2048x1536px
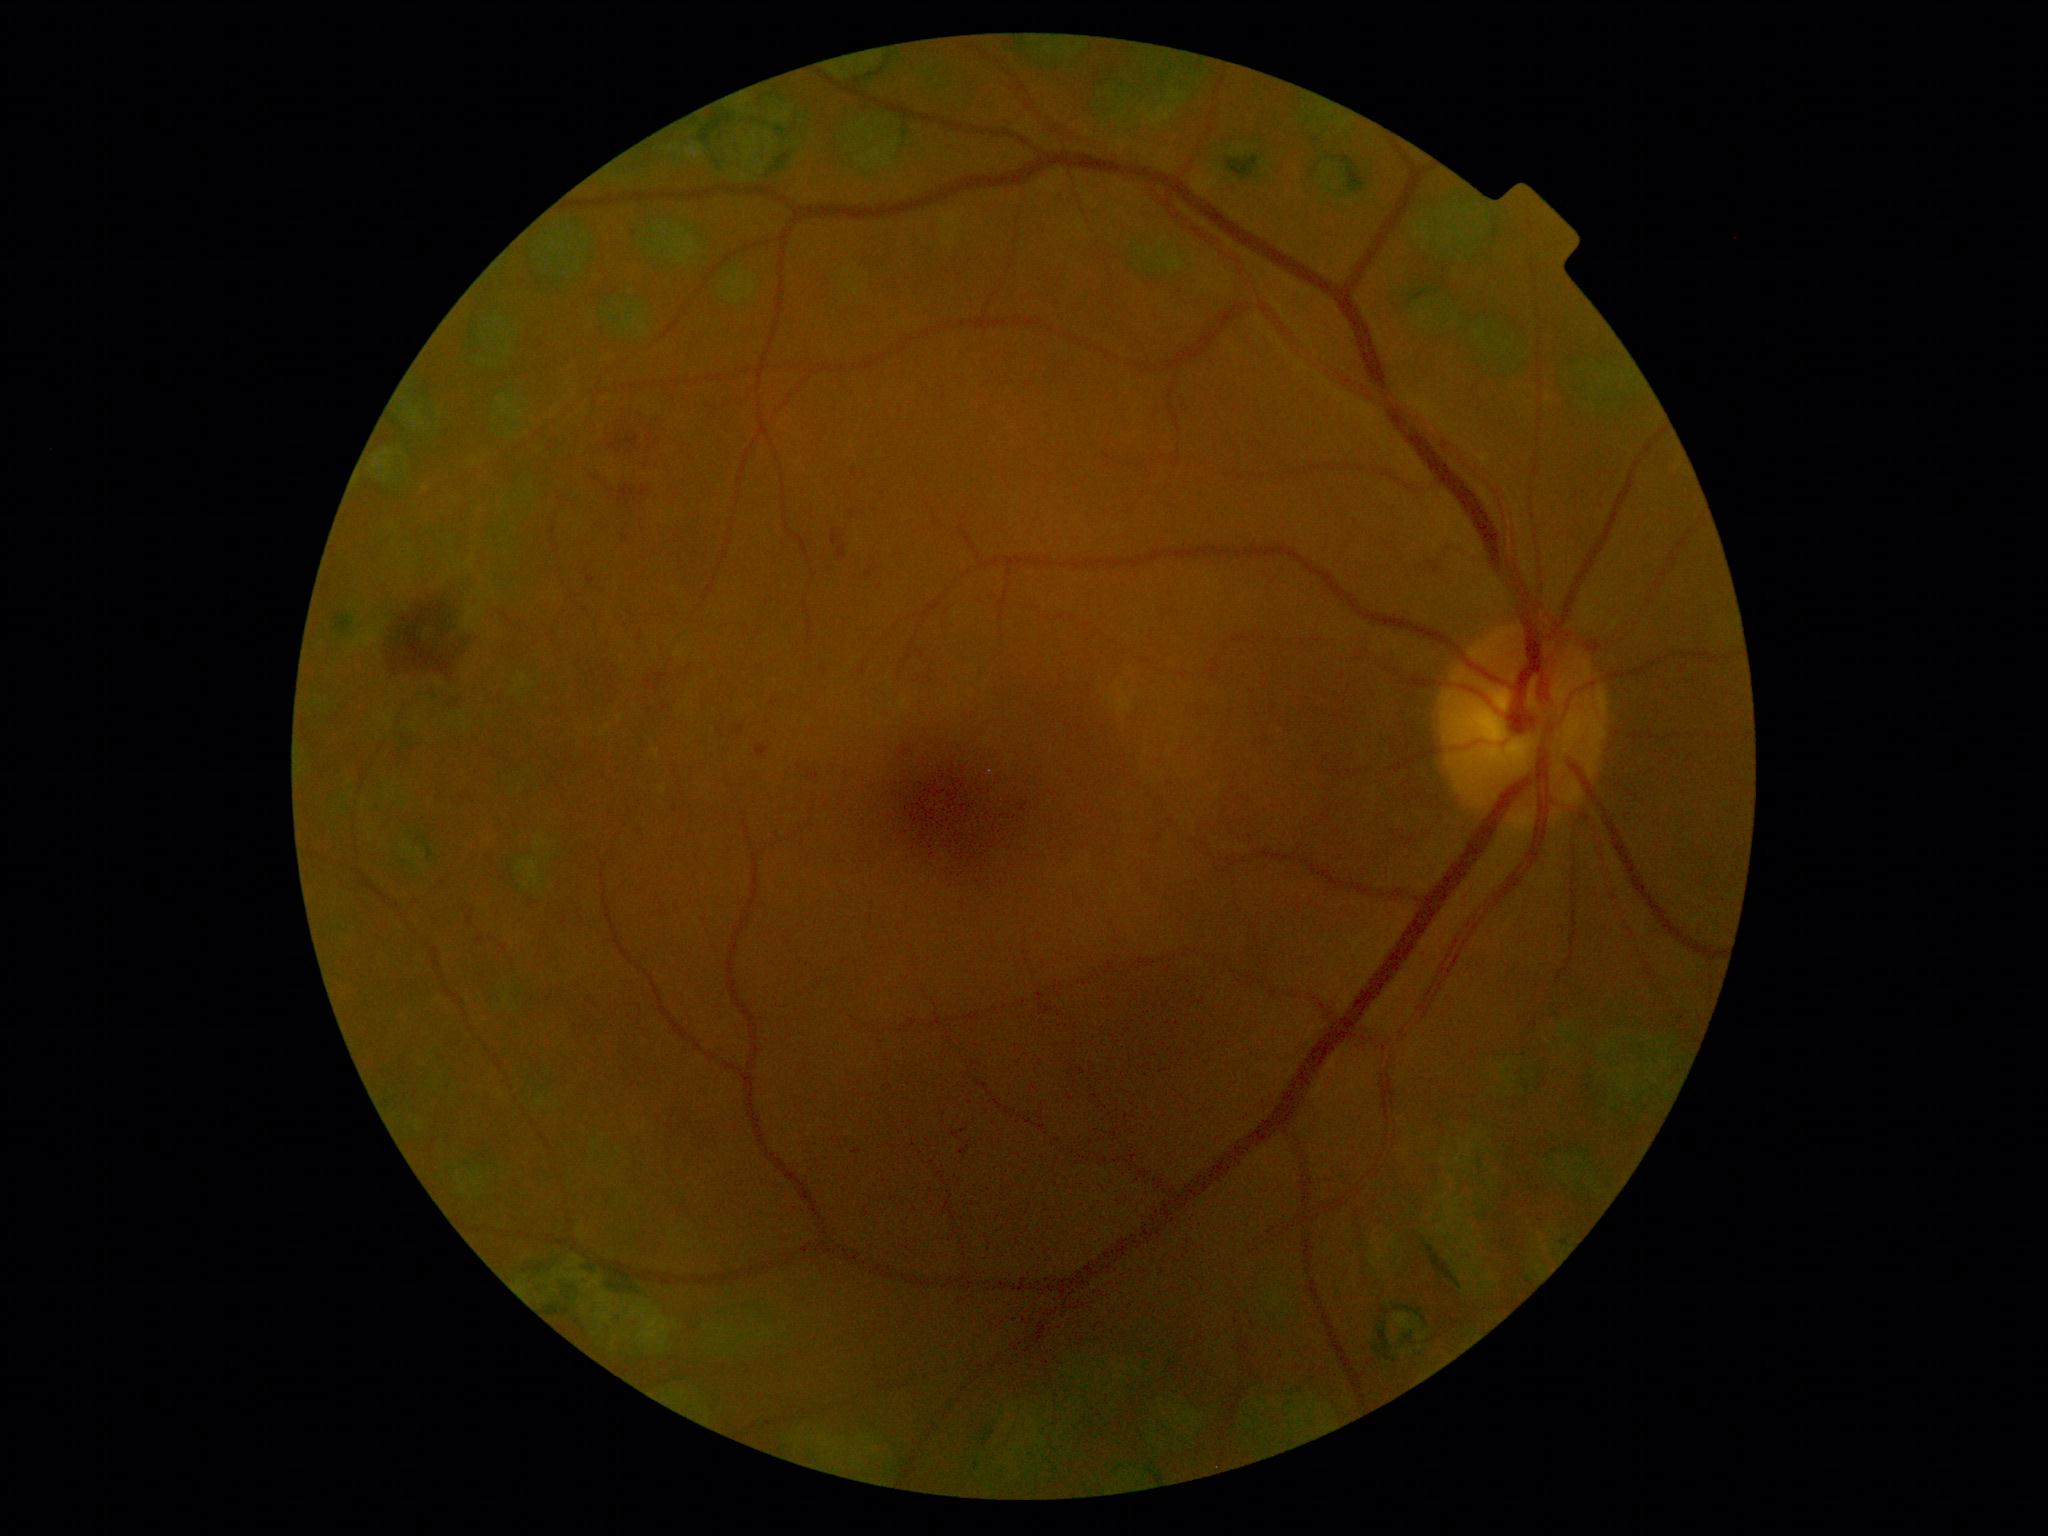
DR severity: moderate non-proliferative diabetic retinopathy (grade 2) — more than just microaneurysms but less than severe NPDR.